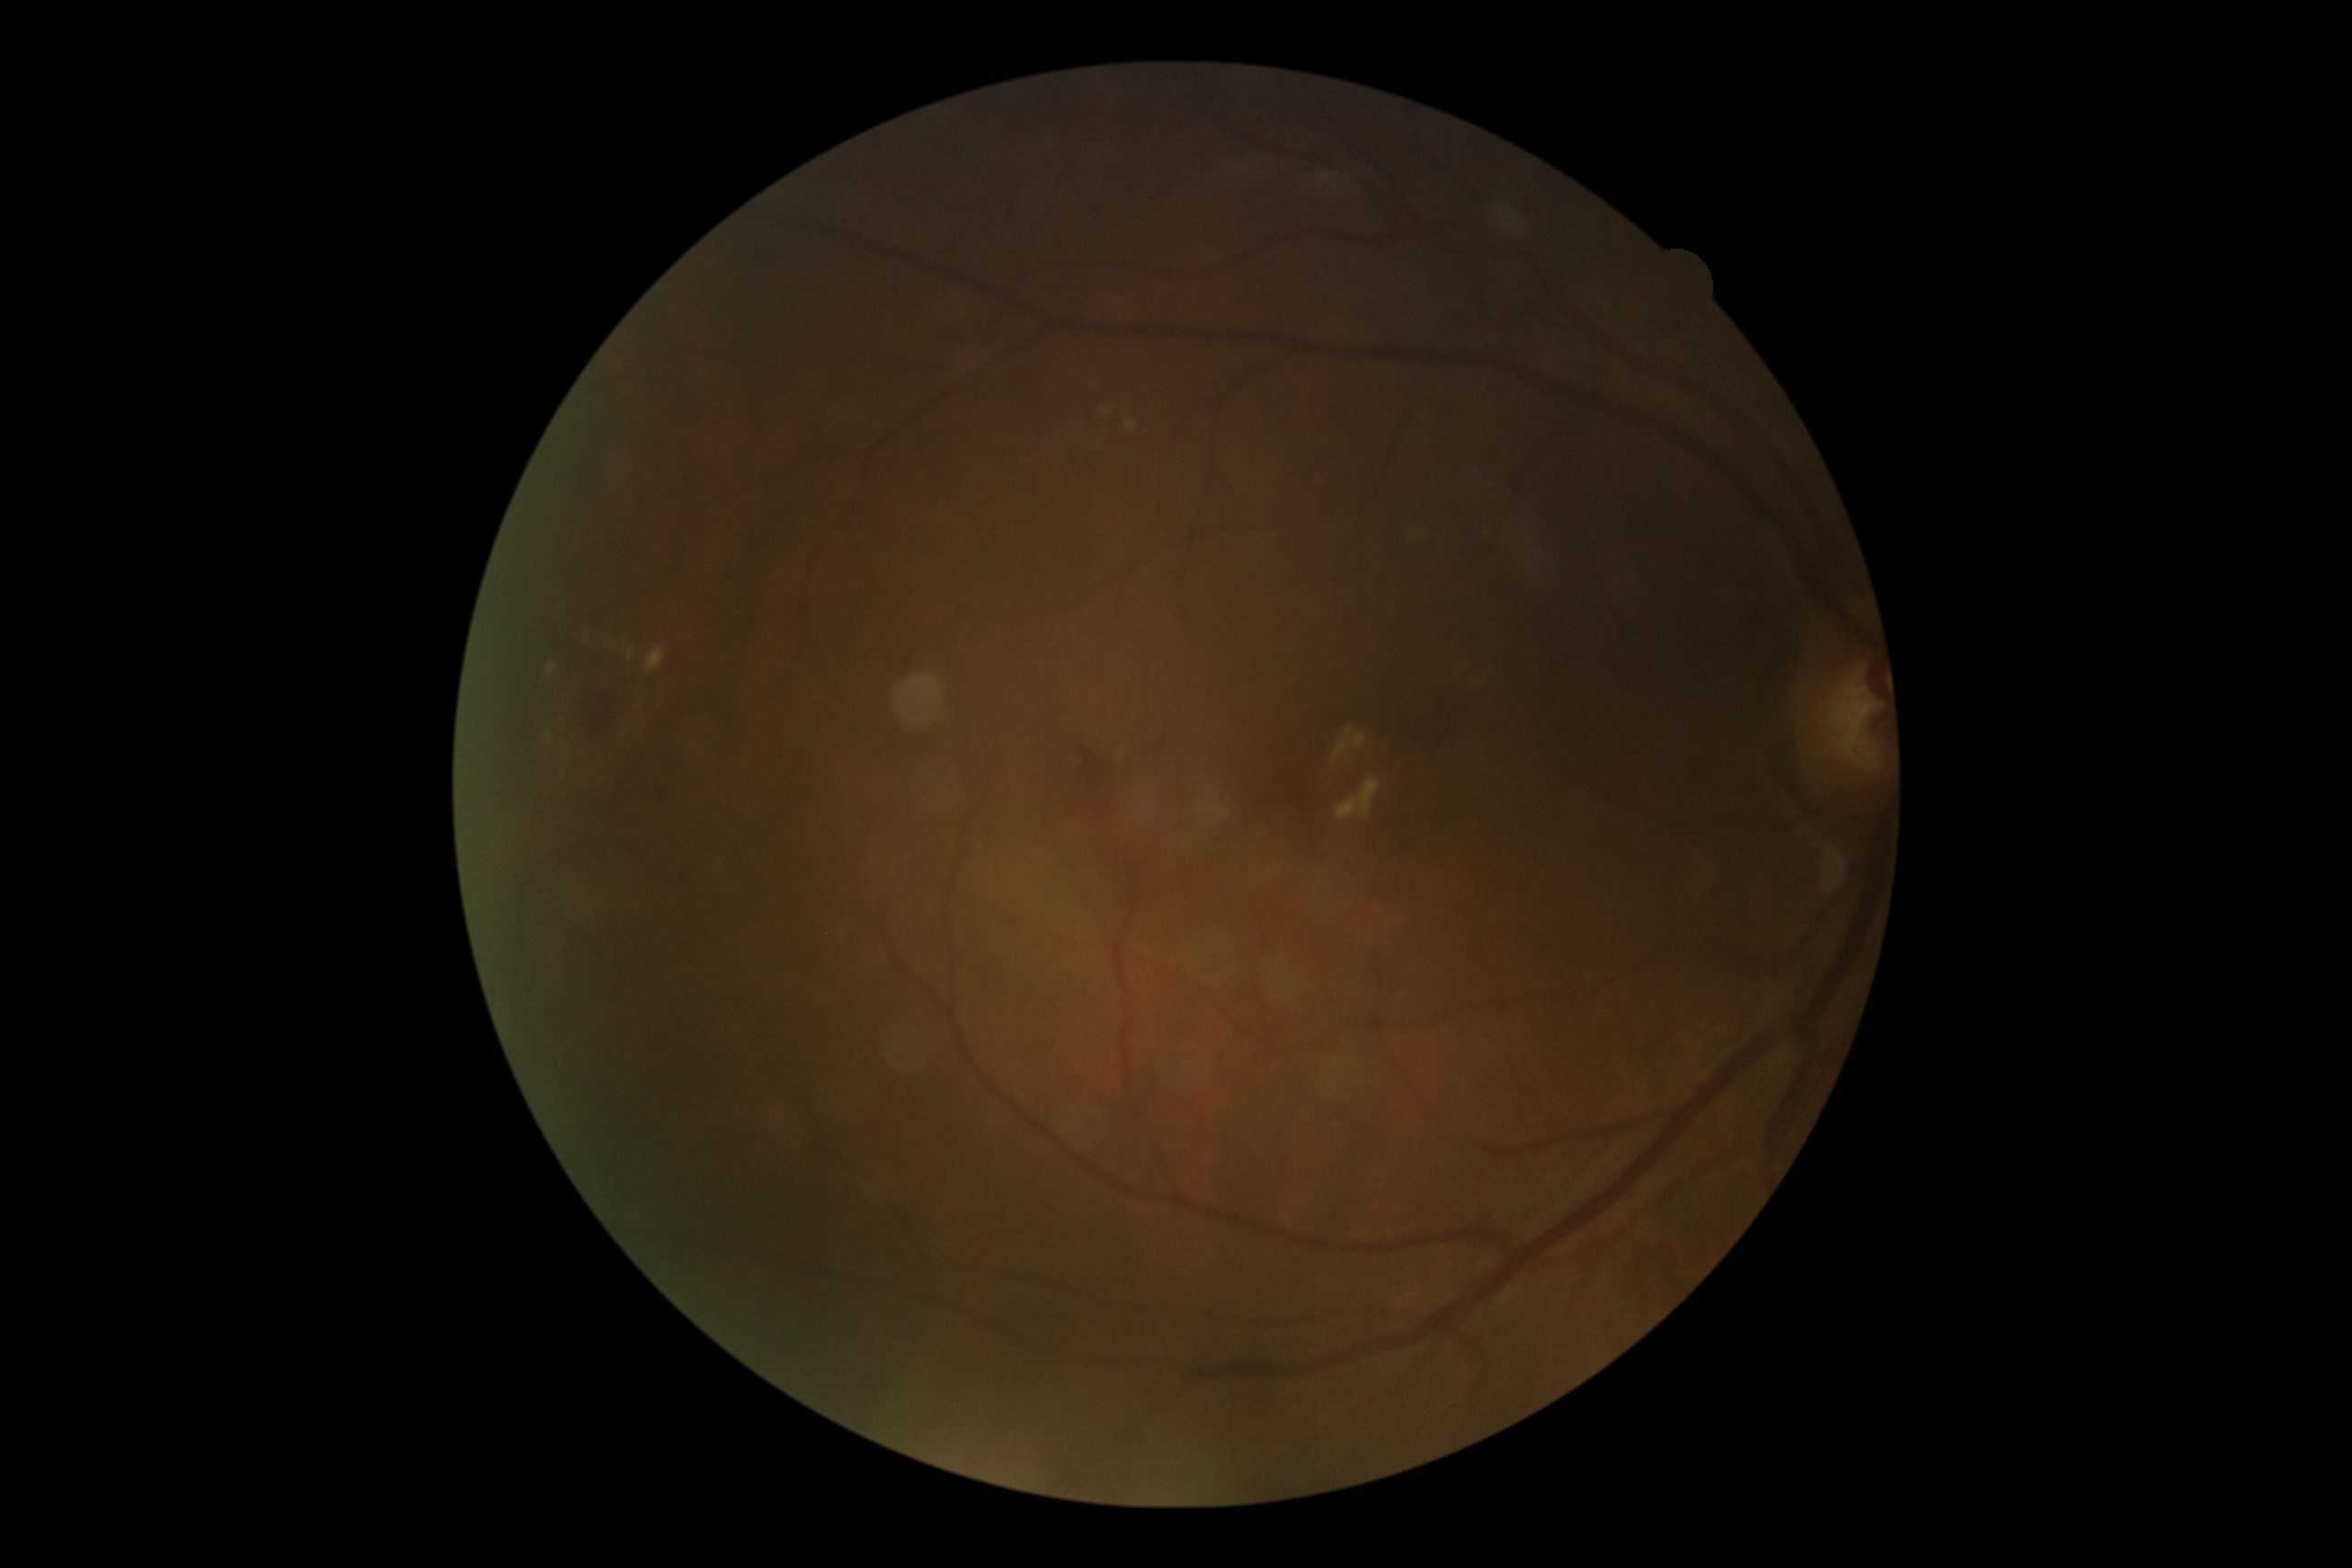

{
  "dr_grade": "2/4"
}